240 x 240 pixels
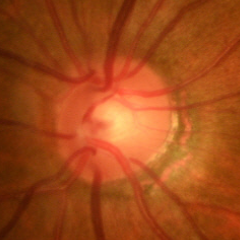

Q: Does this eye have glaucoma?
A: Early glaucoma.